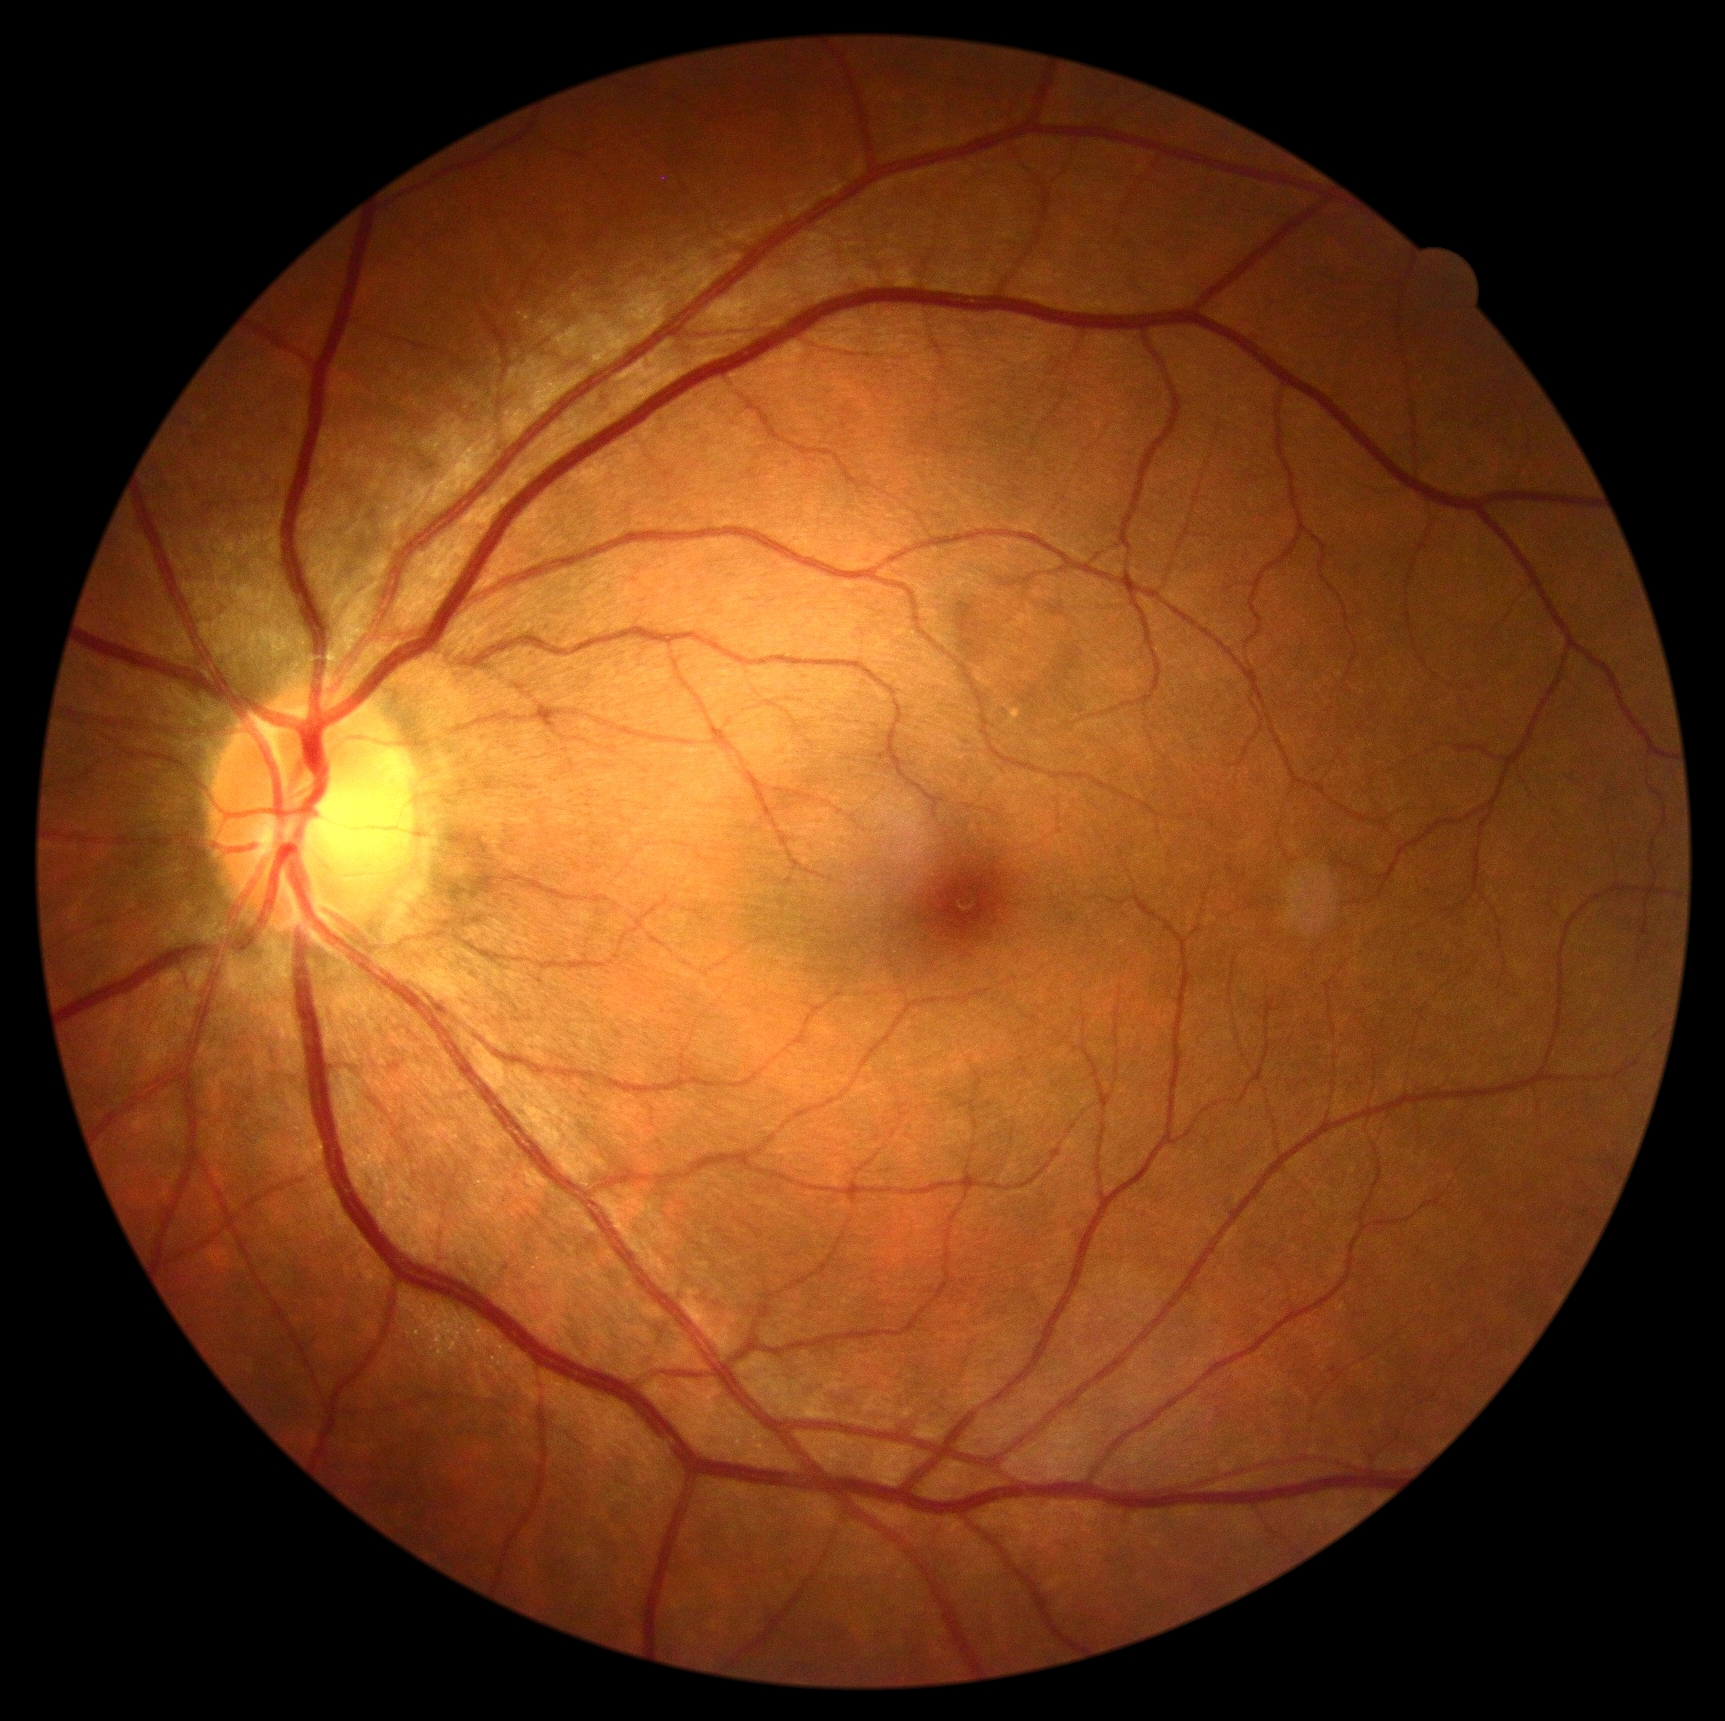
diabetic retinopathy severity = grade 0 — no visible signs of diabetic retinopathy.